Color fundus image
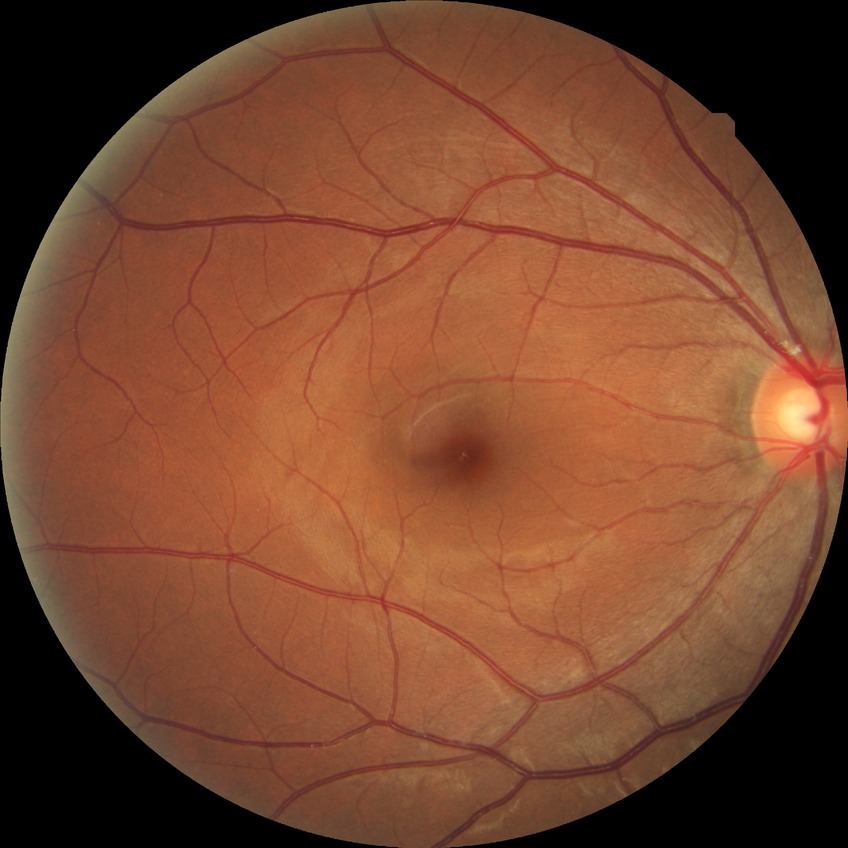
Diabetic retinopathy stage: no diabetic retinopathy.